Infant wide-field retinal image — 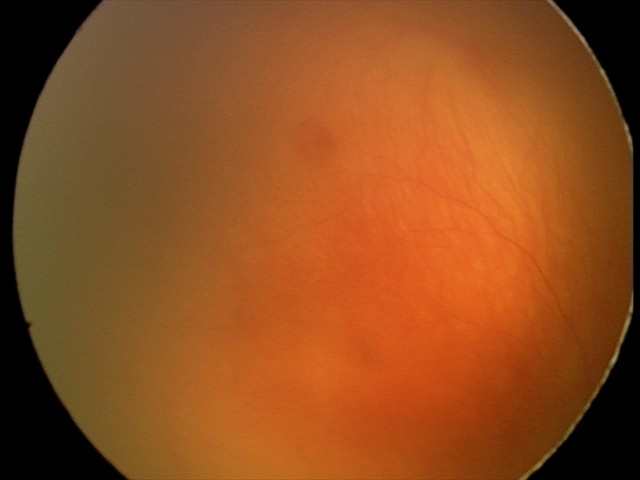 From an examination with diagnosis of aggressive ROP (A-ROP).